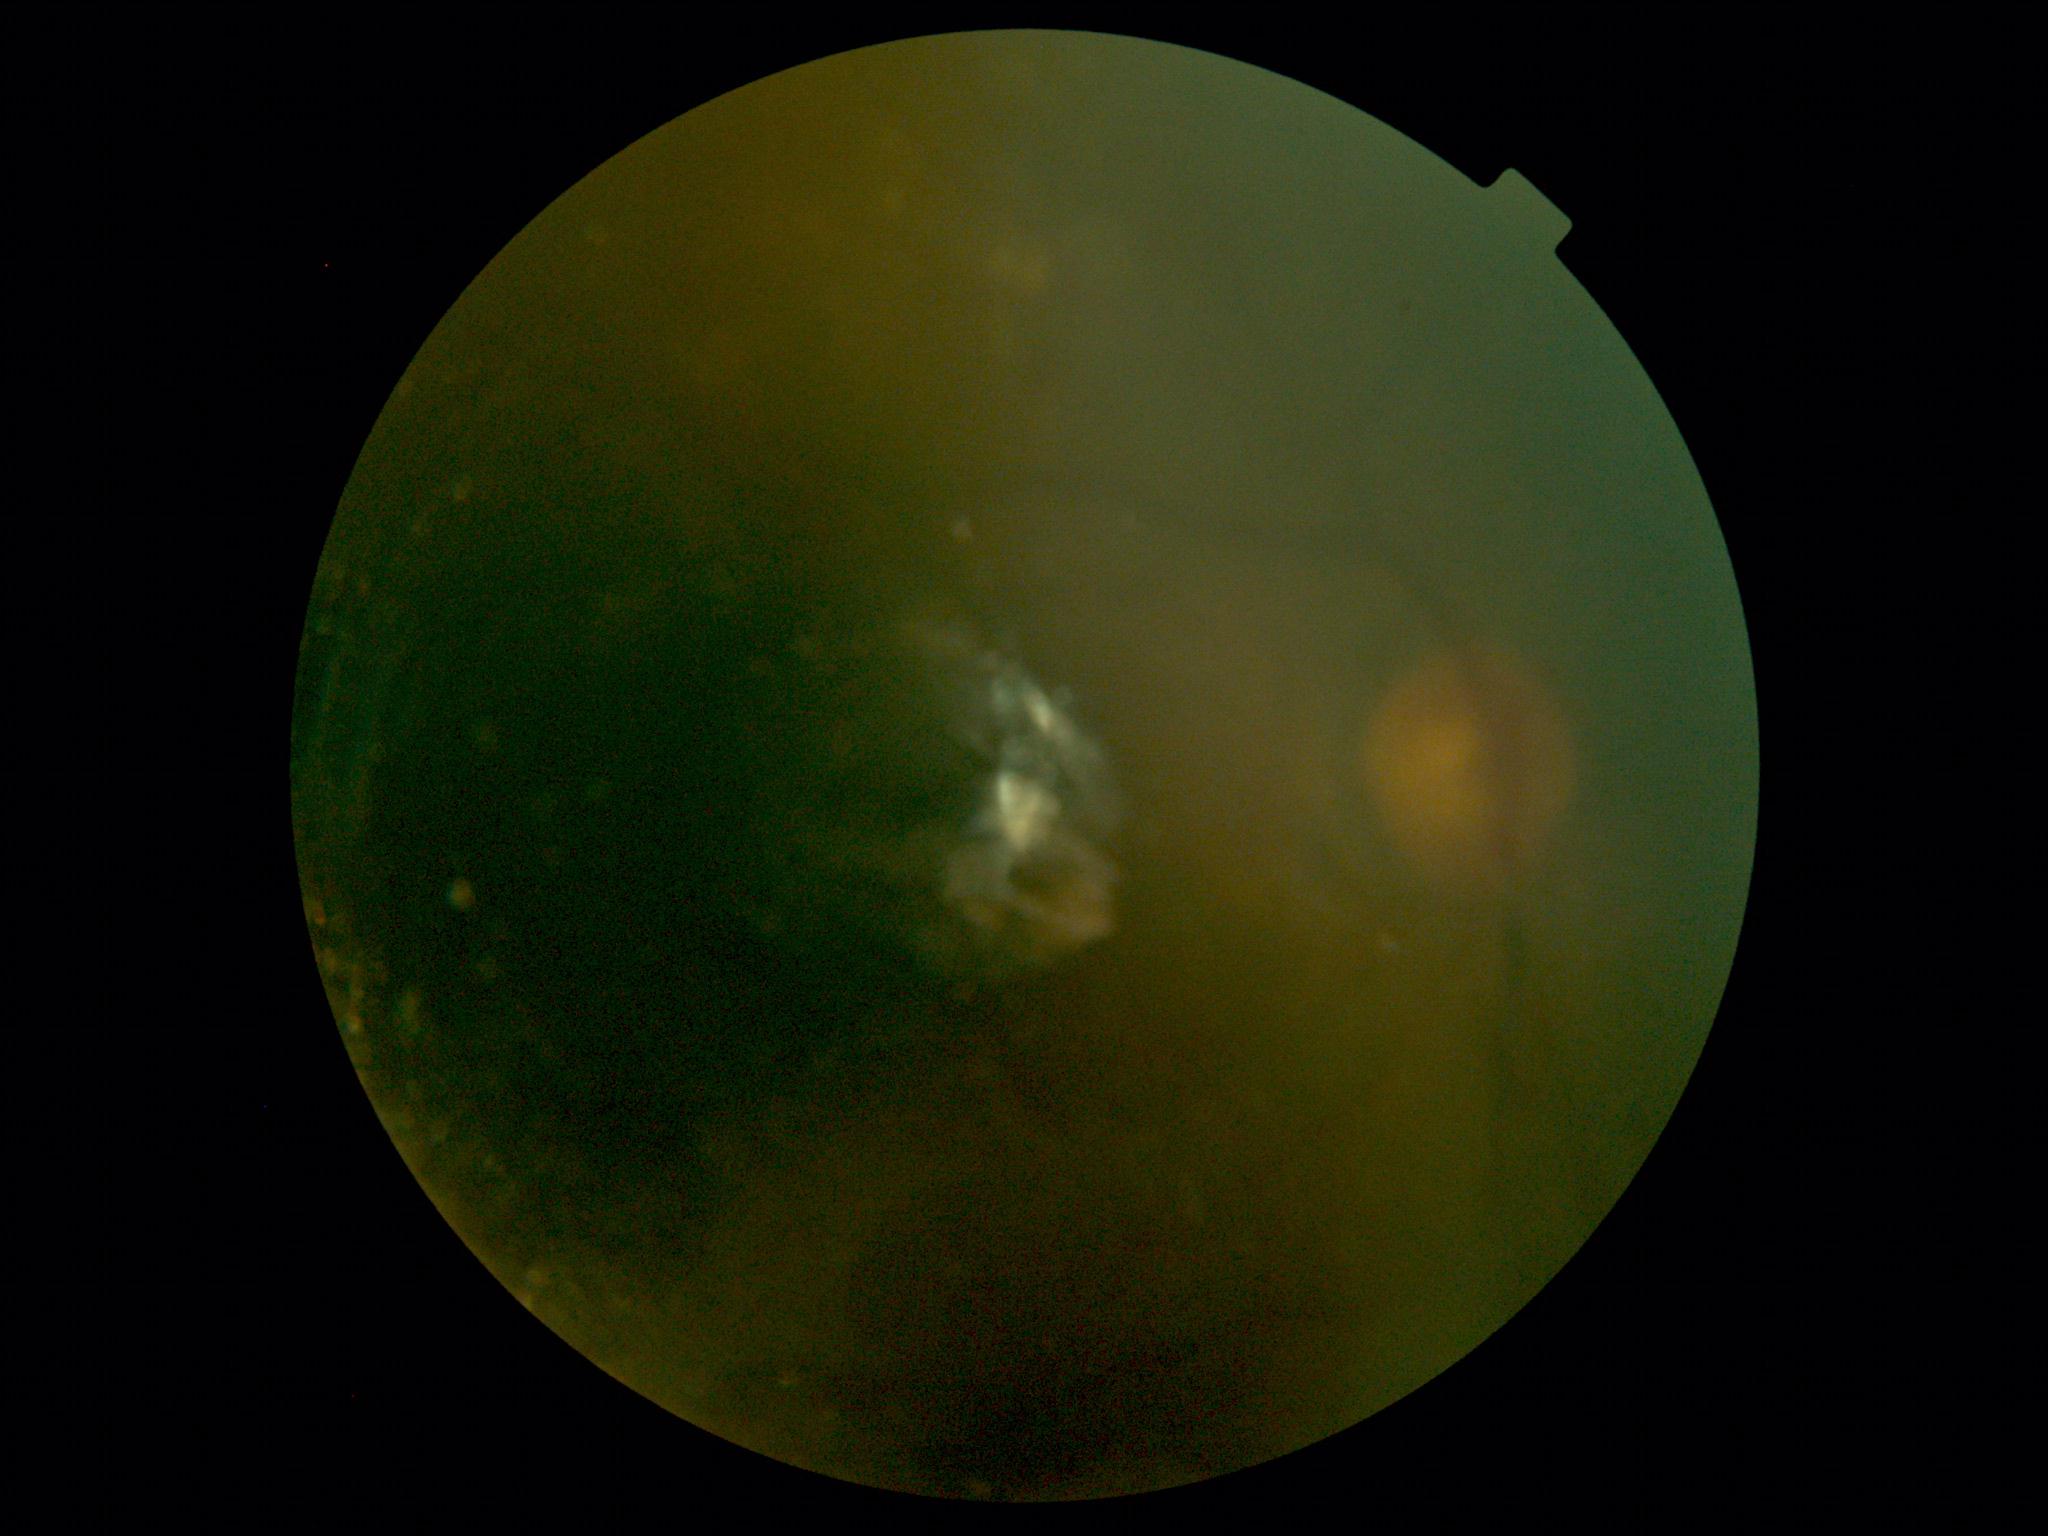
DR: ungradable.